Davis DR grading.
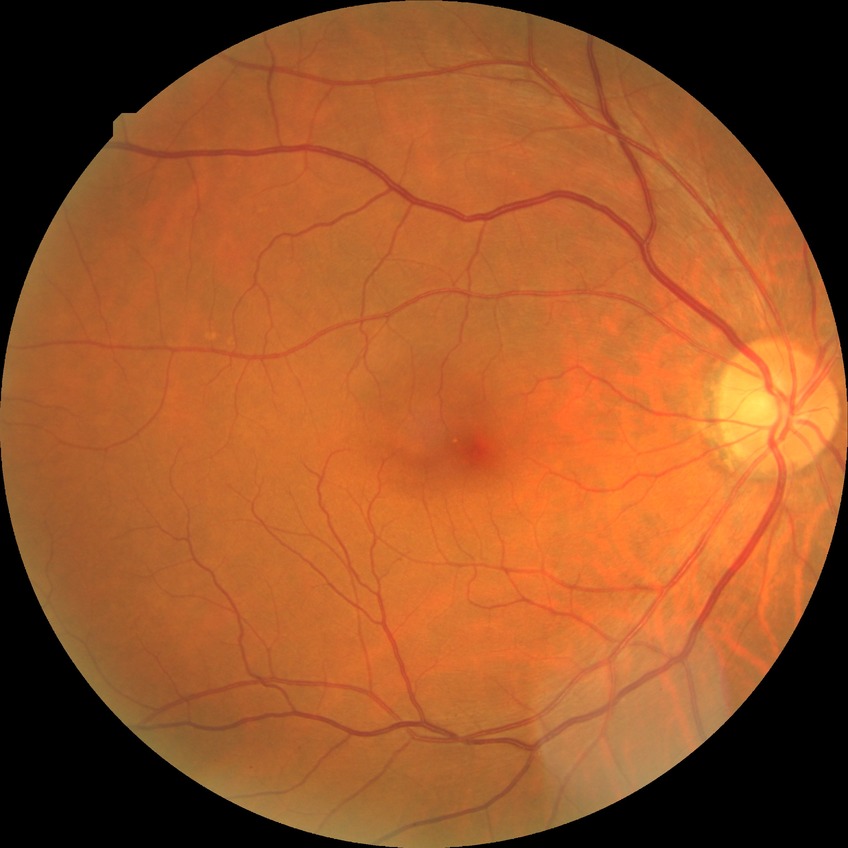
DR stage: NDR.